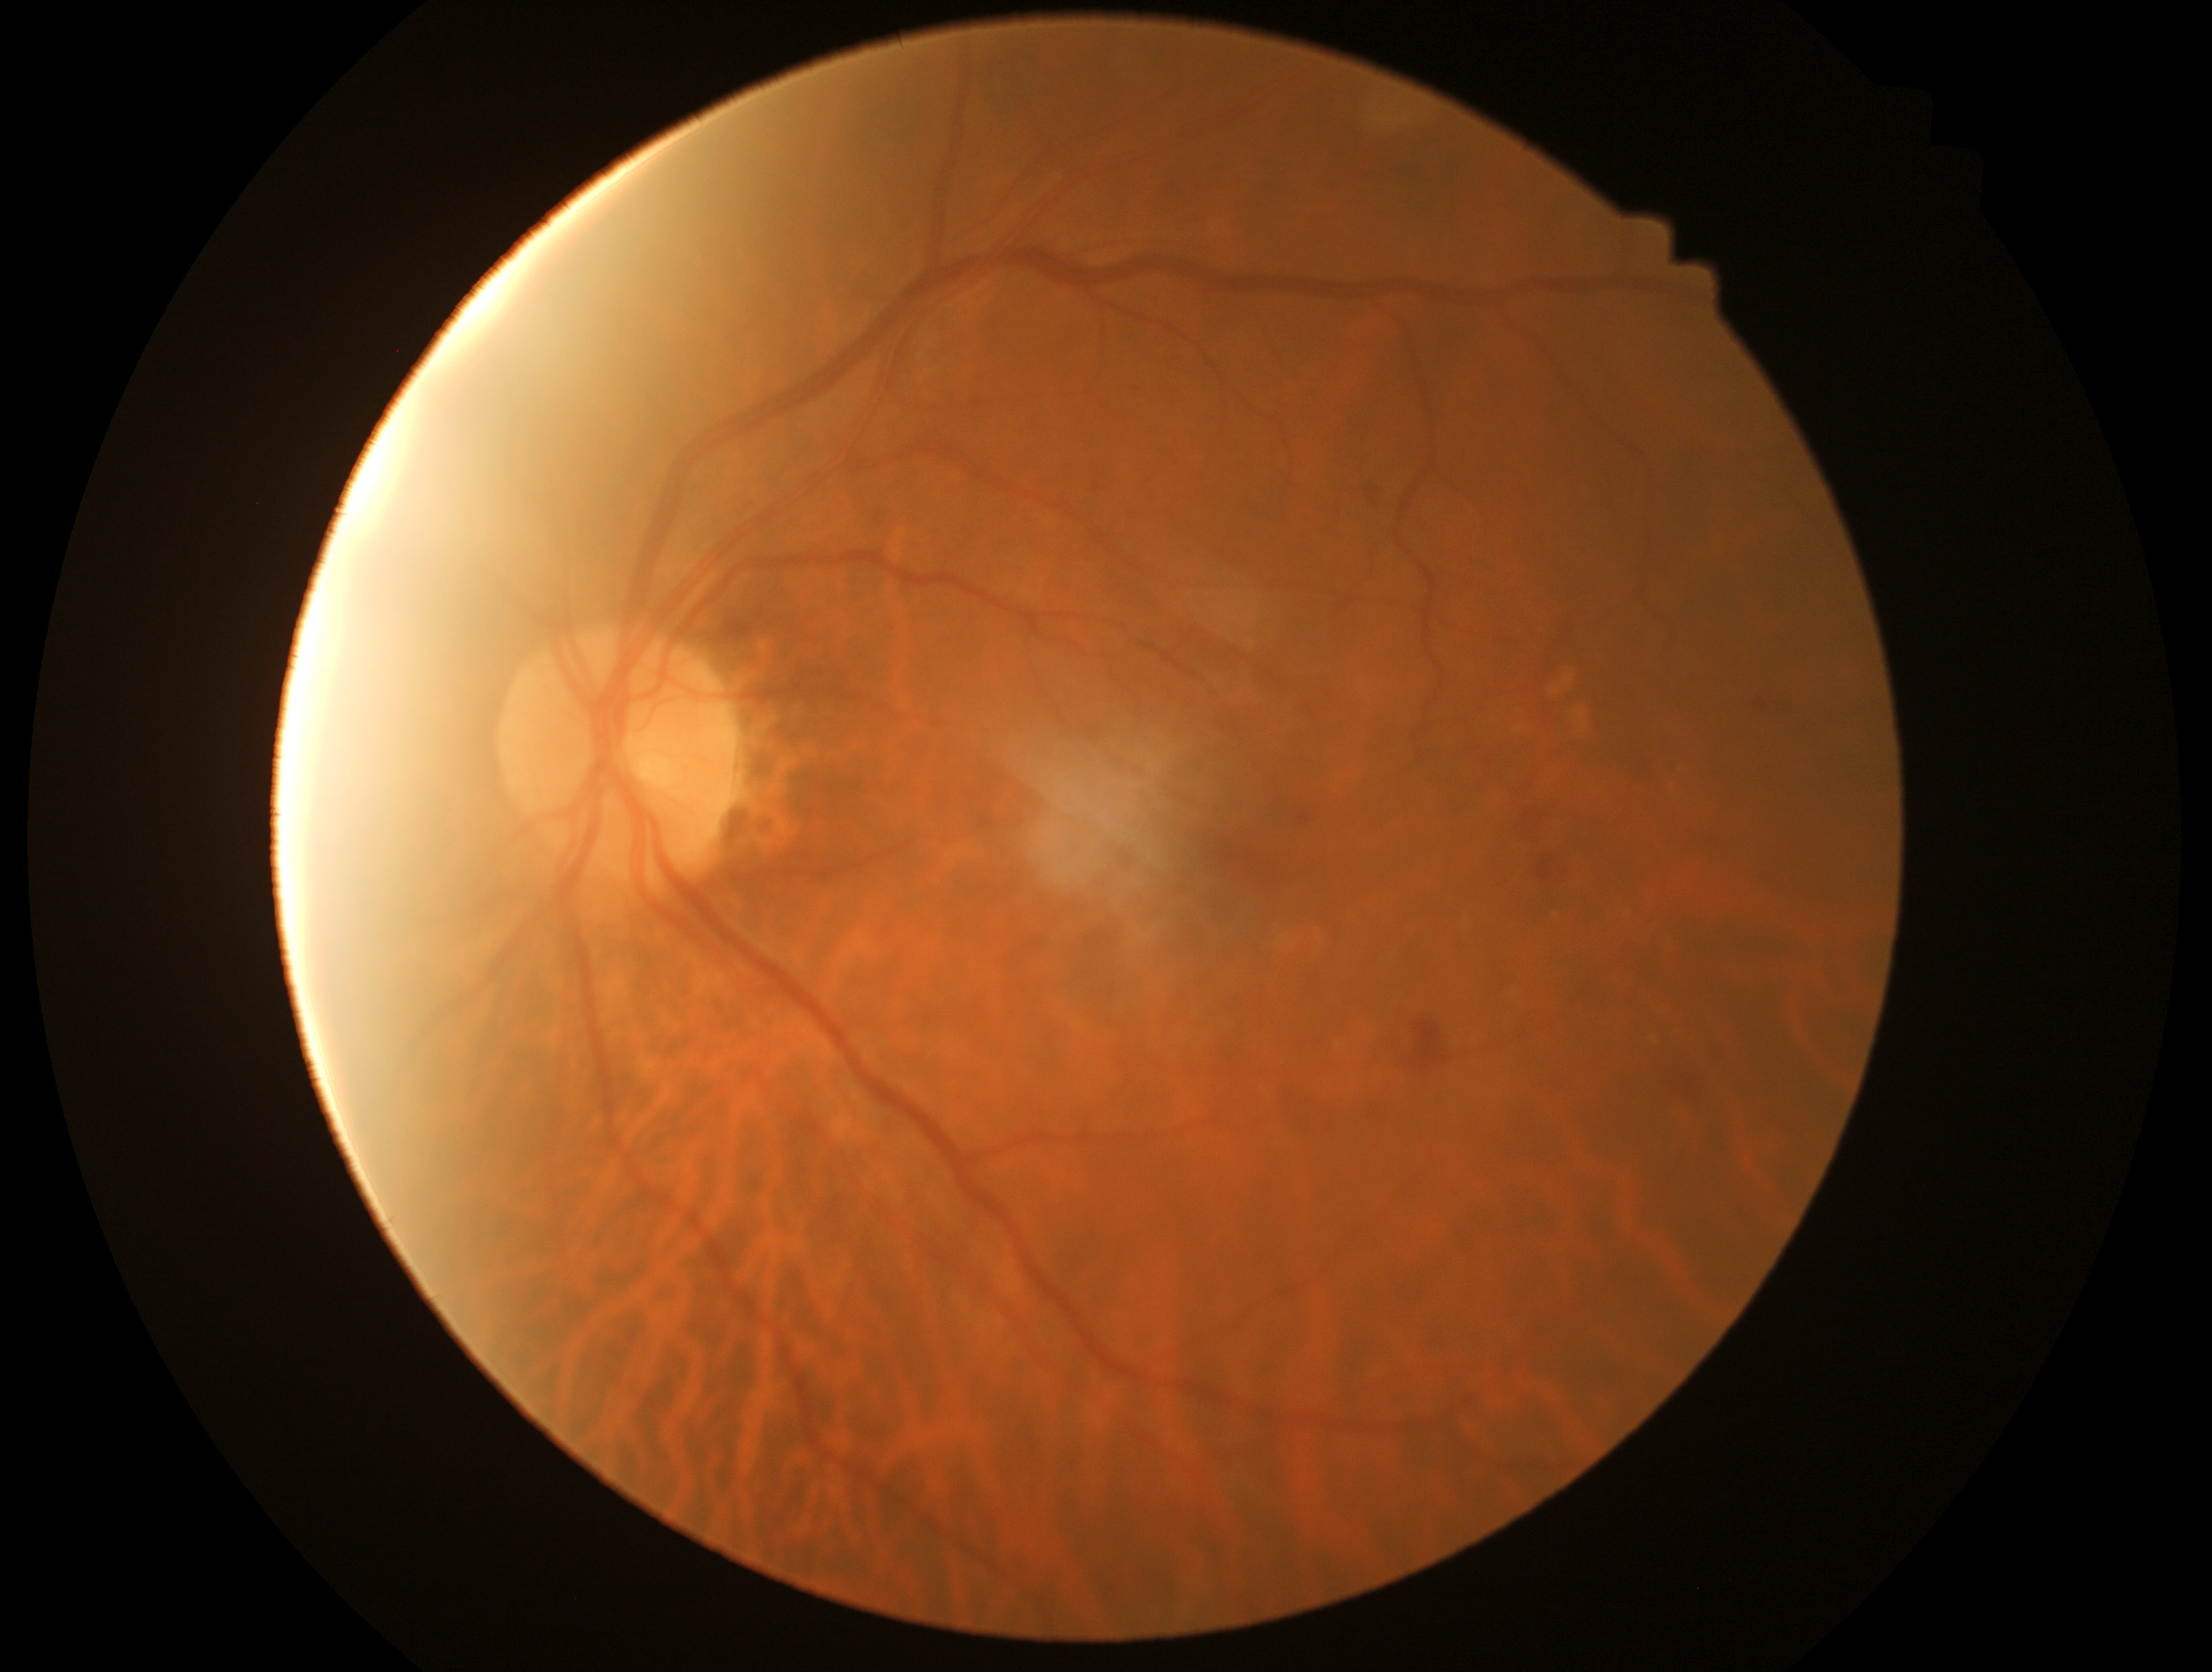
DR class: non-proliferative diabetic retinopathy. Diabetic retinopathy grade: 2.